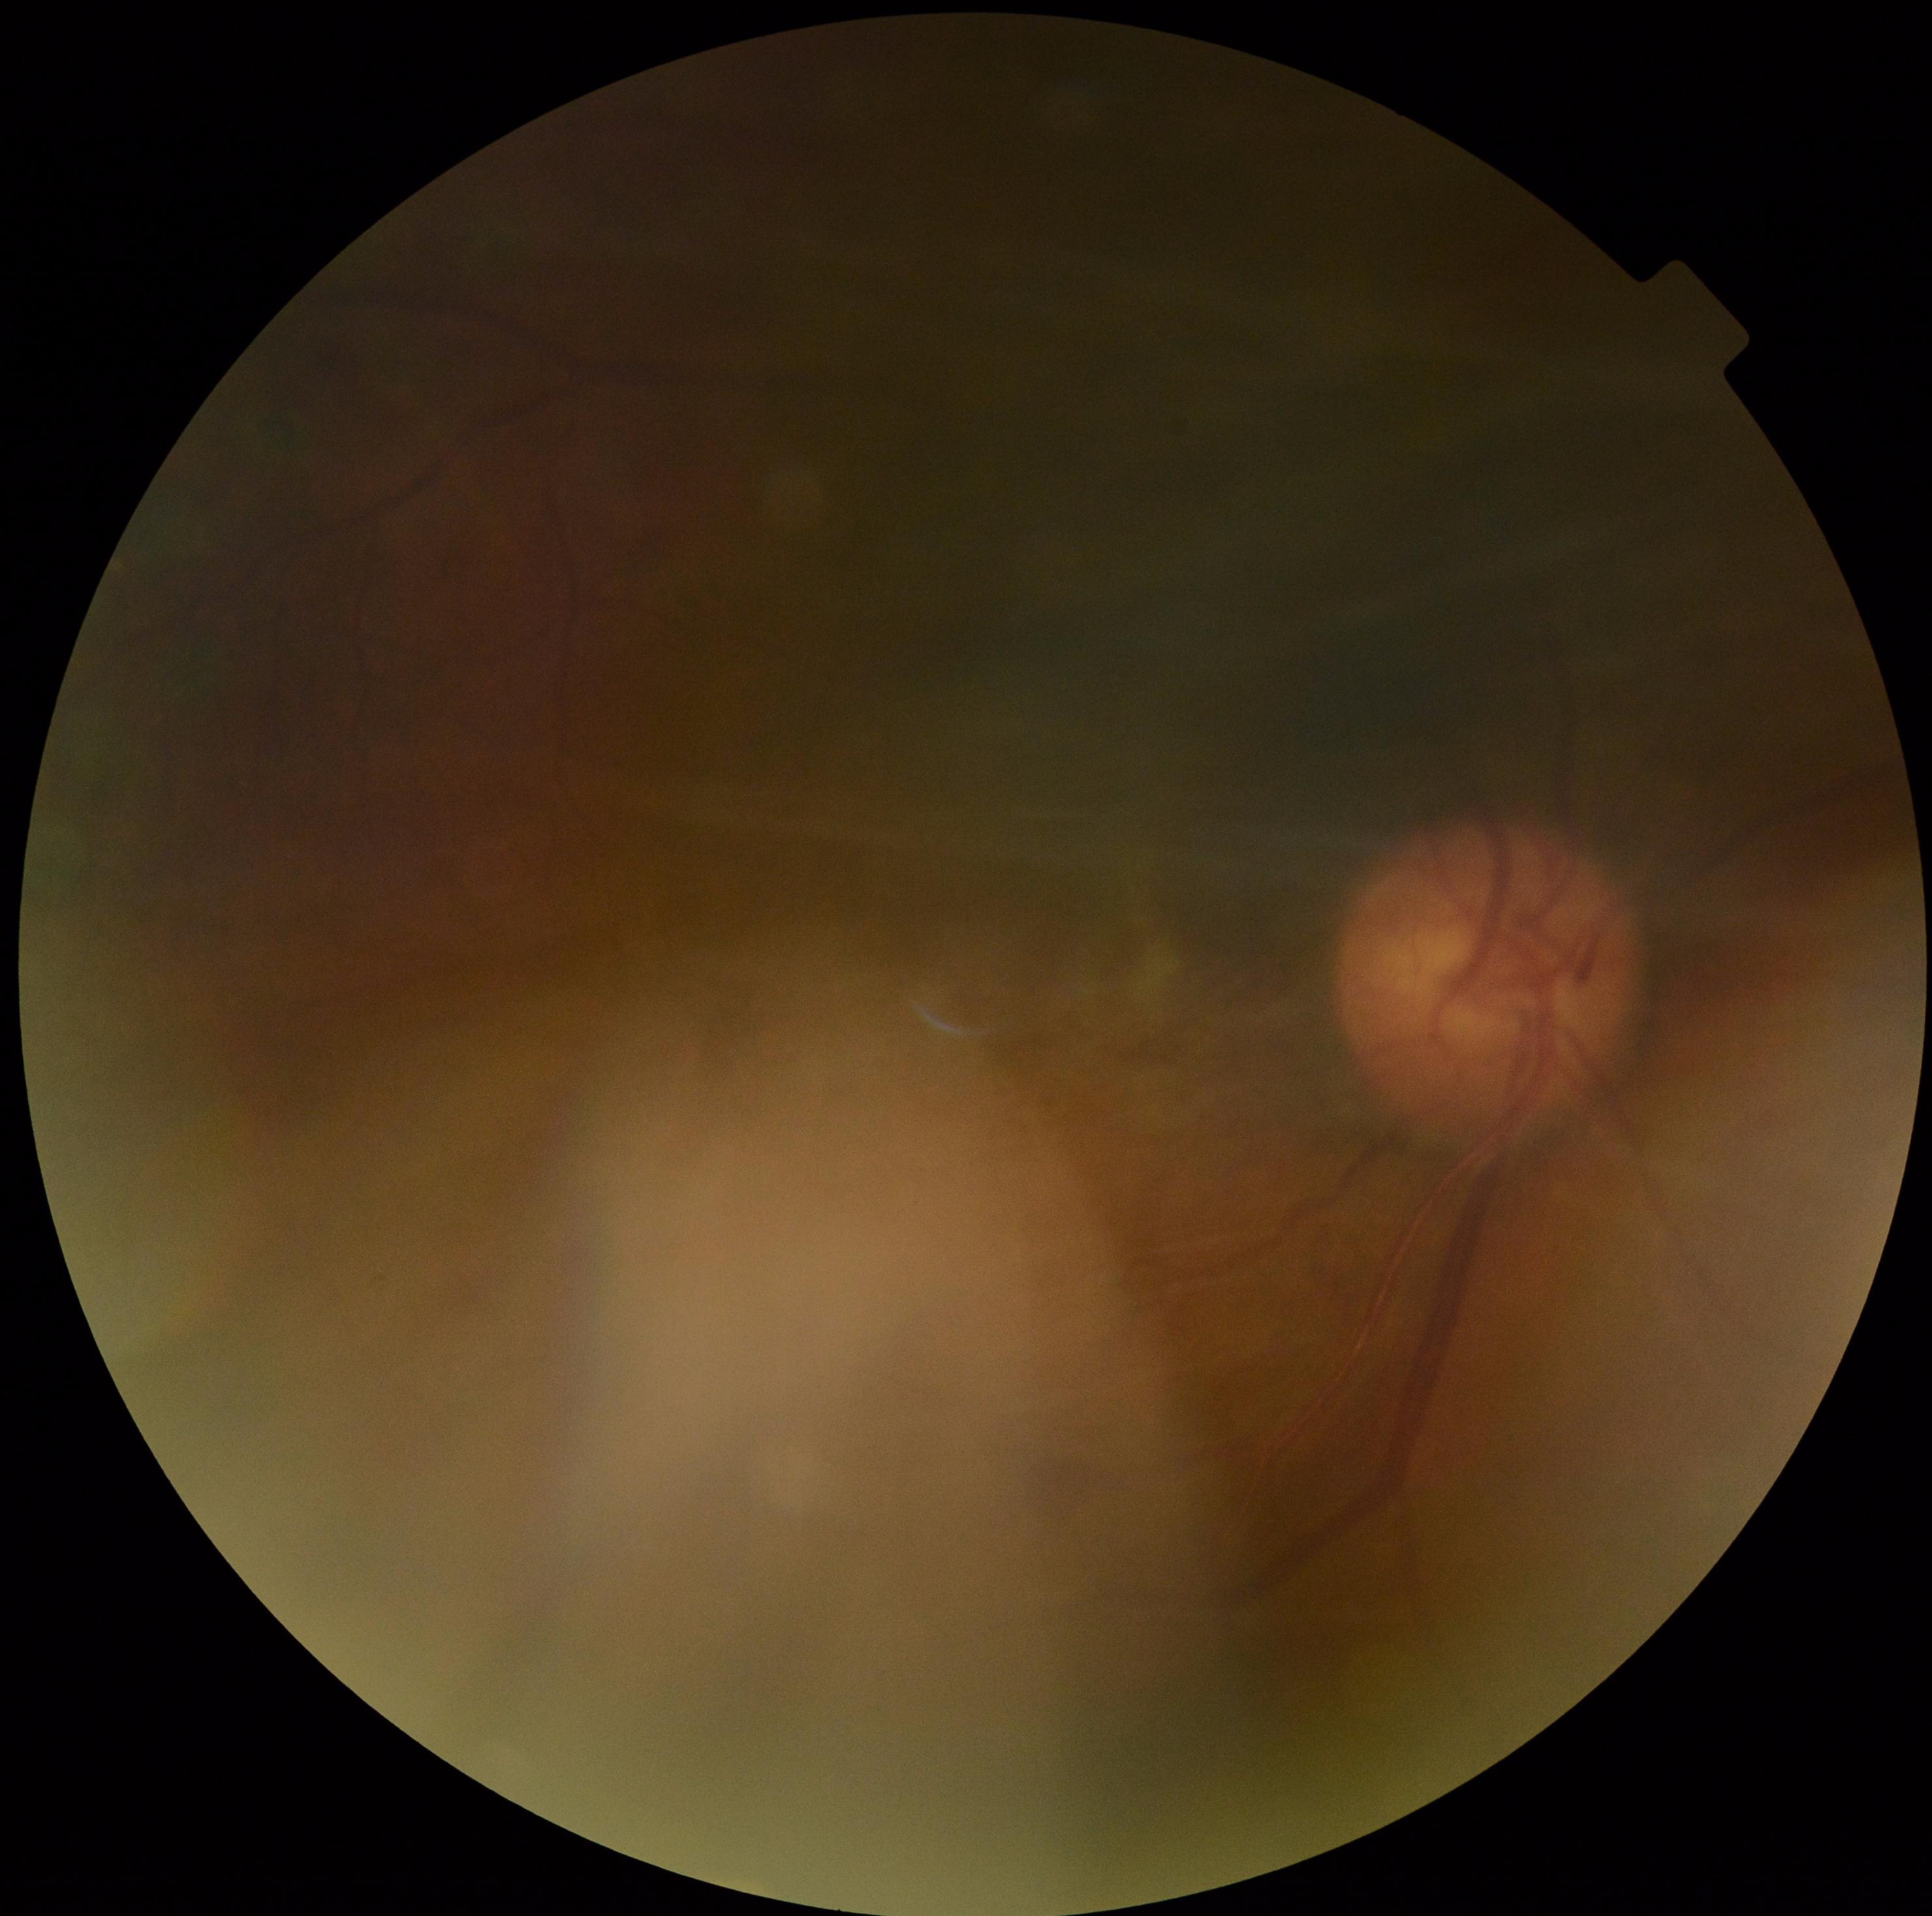

DR severity: ungradable due to poor image quality.